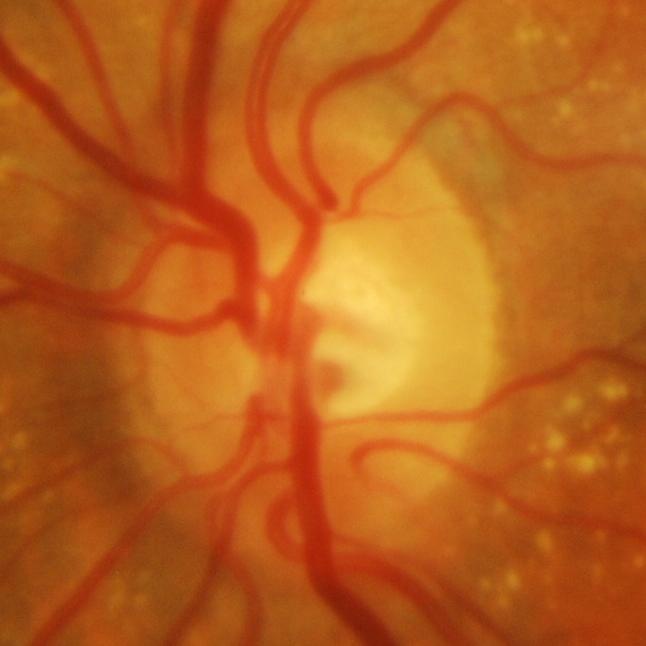

Optic disc appearance consistent with evidence of glaucoma.